Pediatric retinal photograph (wide-field); 1240 x 1240 pixels: 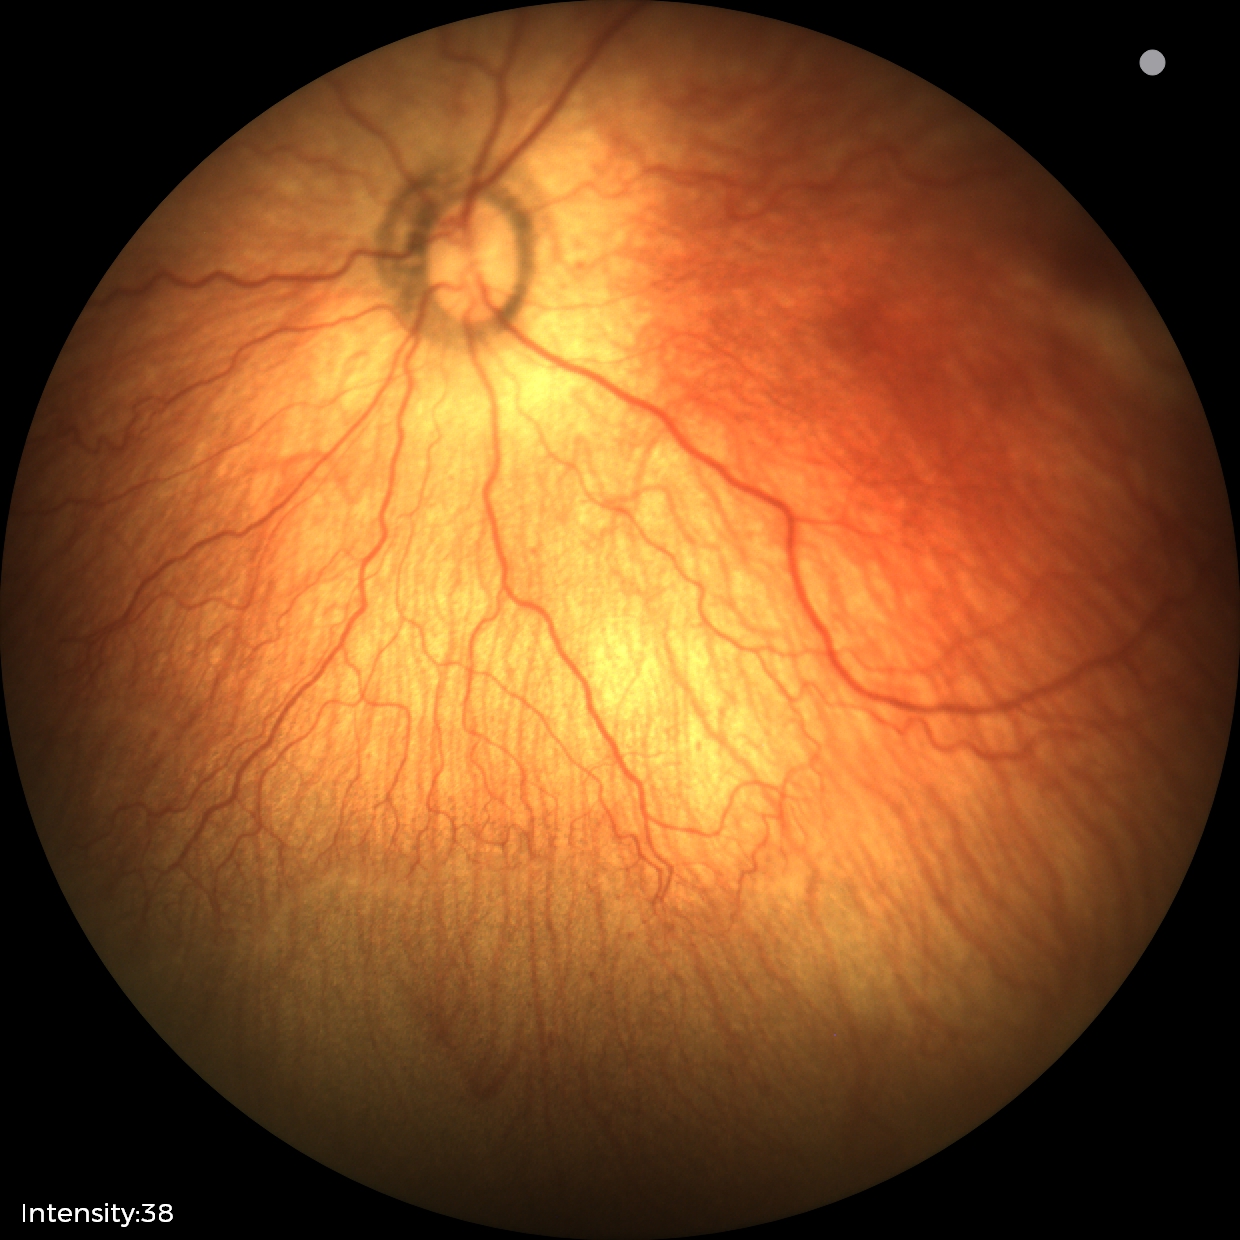
Screening diagnosis: no plus disease | retinopathy of prematurity stage 1.